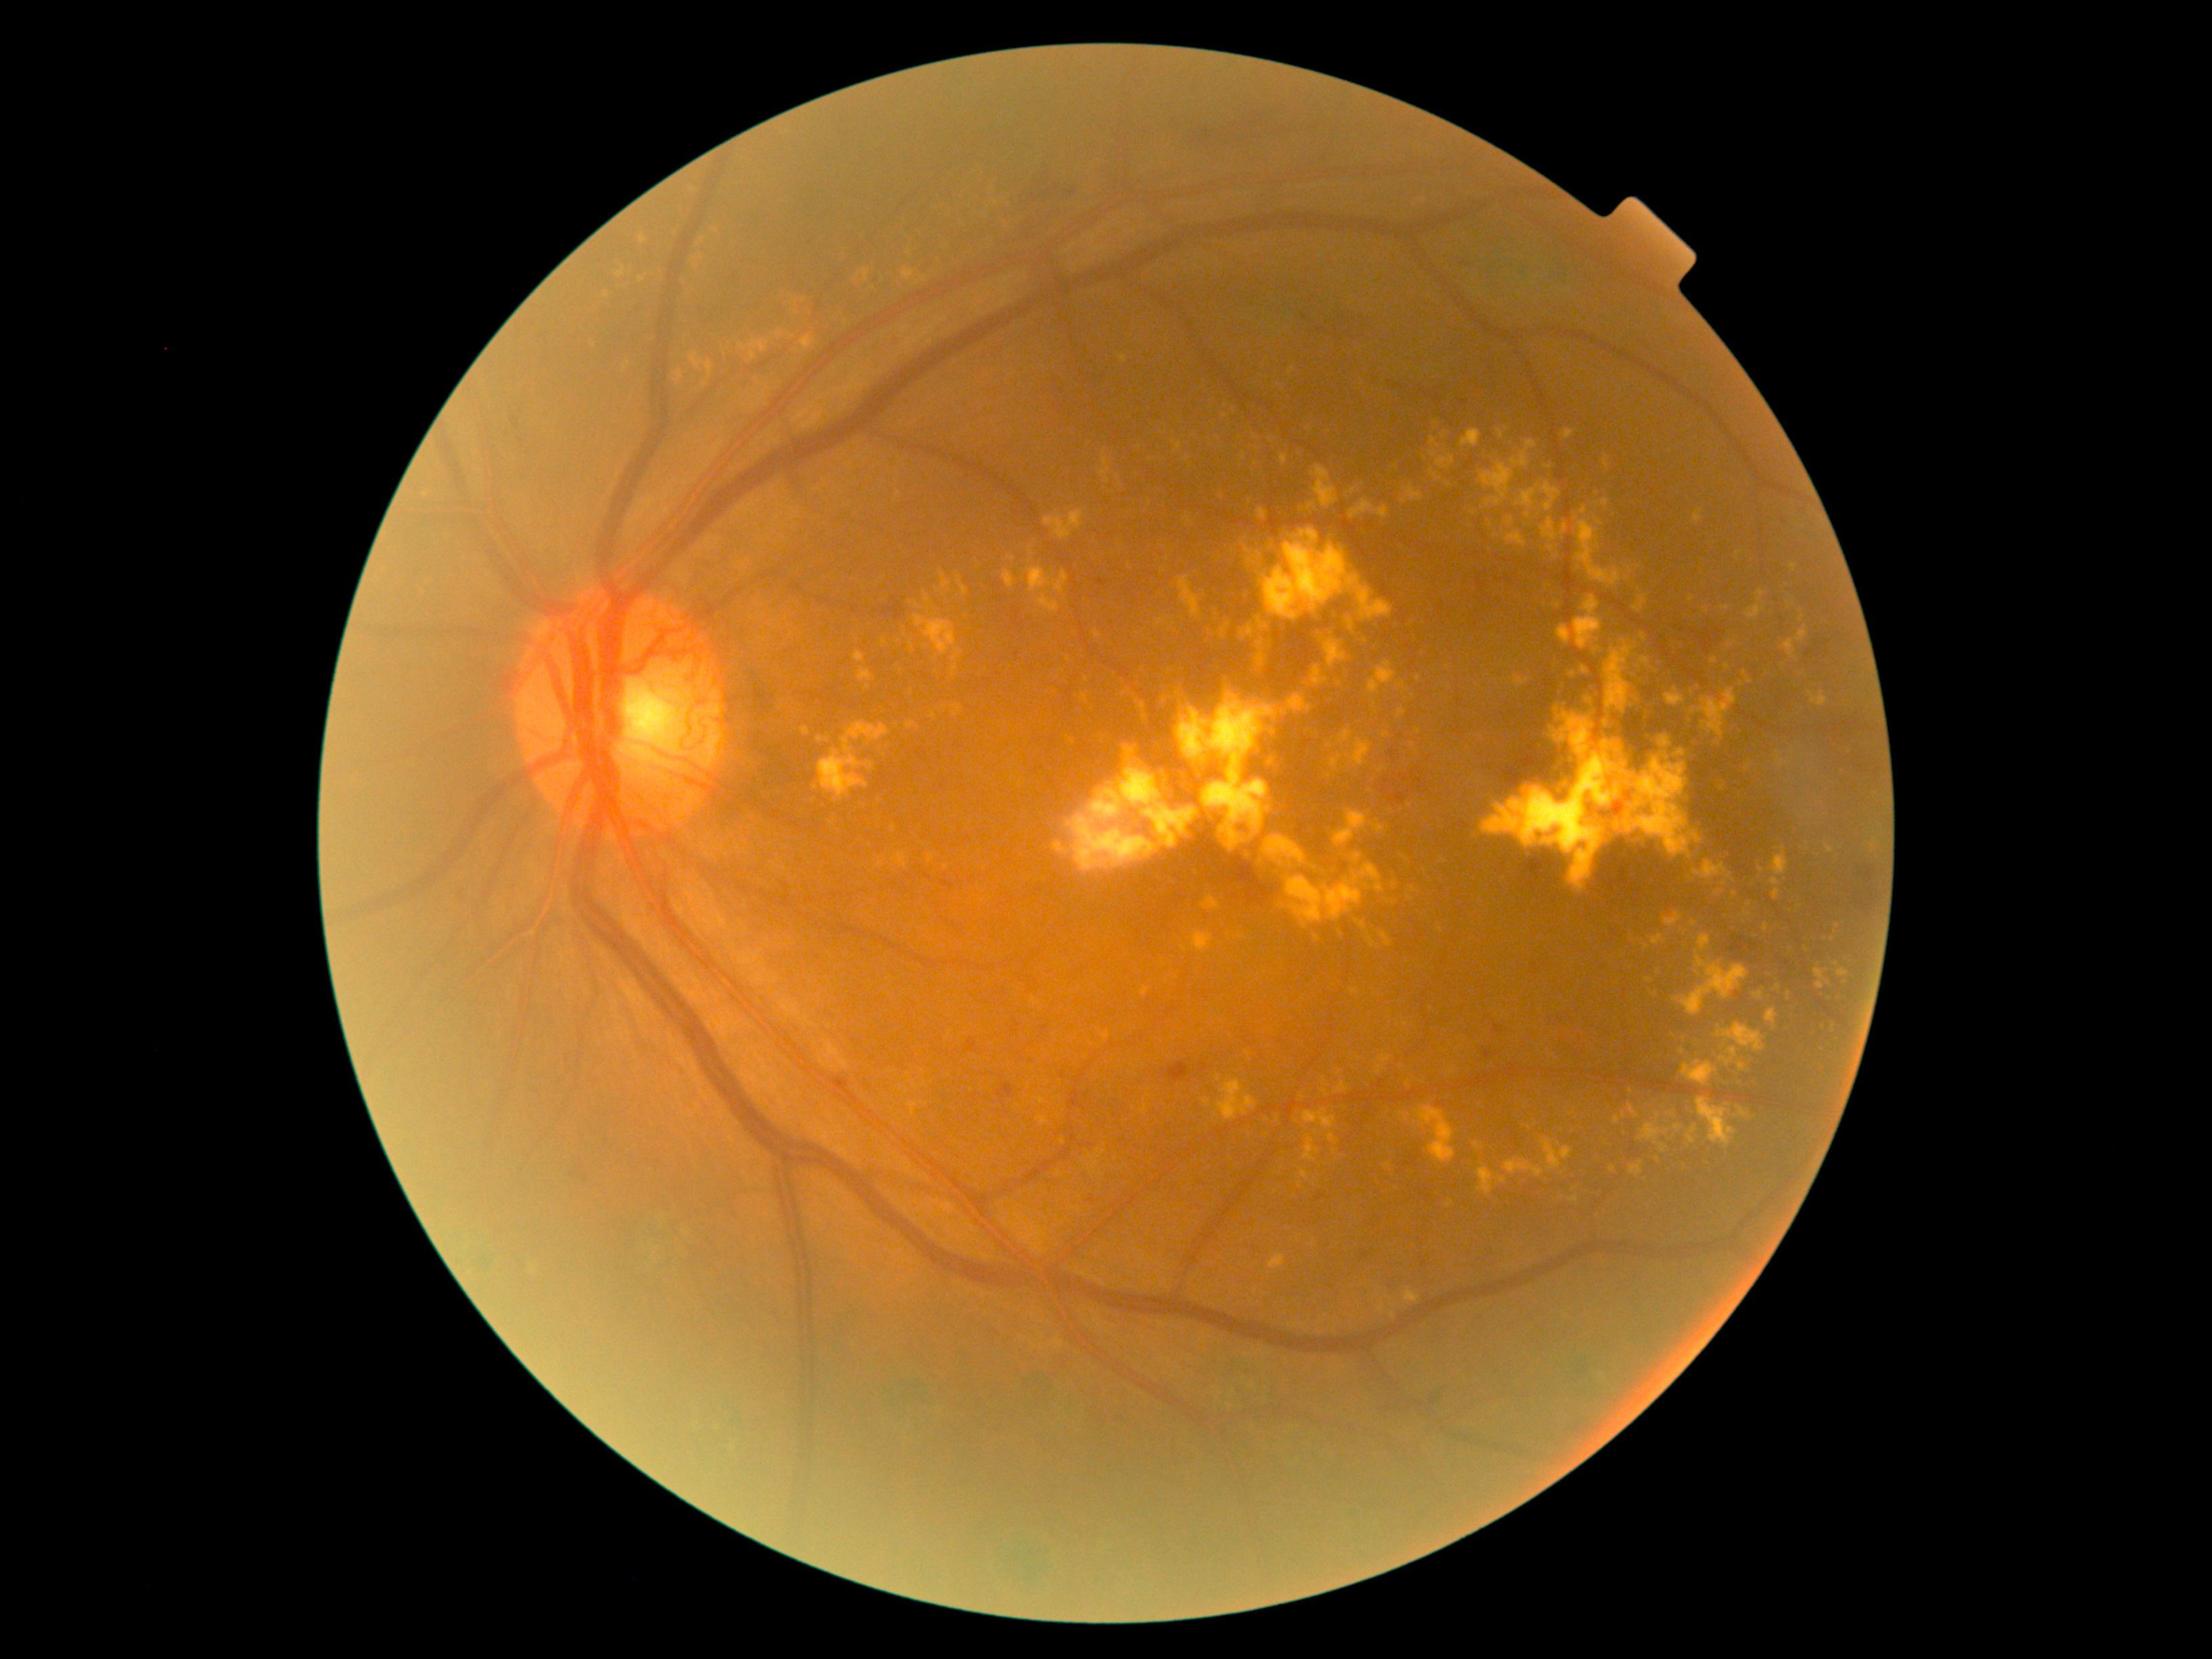
DR is PDR (grade 4). EXs are present, including at <region>1371, 823, 1385, 833</region> | <region>1740, 1109, 1756, 1124</region> | <region>1338, 932, 1344, 940</region> | <region>855, 269, 871, 280</region> | <region>1271, 544, 1275, 552</region> | <region>1516, 1181, 1527, 1187</region> | <region>1511, 441, 1538, 467</region> | <region>1436, 452, 1455, 470</region> | <region>1244, 853, 1249, 863</region> | <region>1371, 708, 1383, 715</region> | <region>1299, 604, 1307, 612</region> | <region>1258, 509, 1268, 520</region> | <region>914, 615, 958, 655</region>. Smaller EXs around 1697/974 | 995/203 | 1725/884 | 1265/1116 | 1837/964 | 1735/895 | 1434/455.